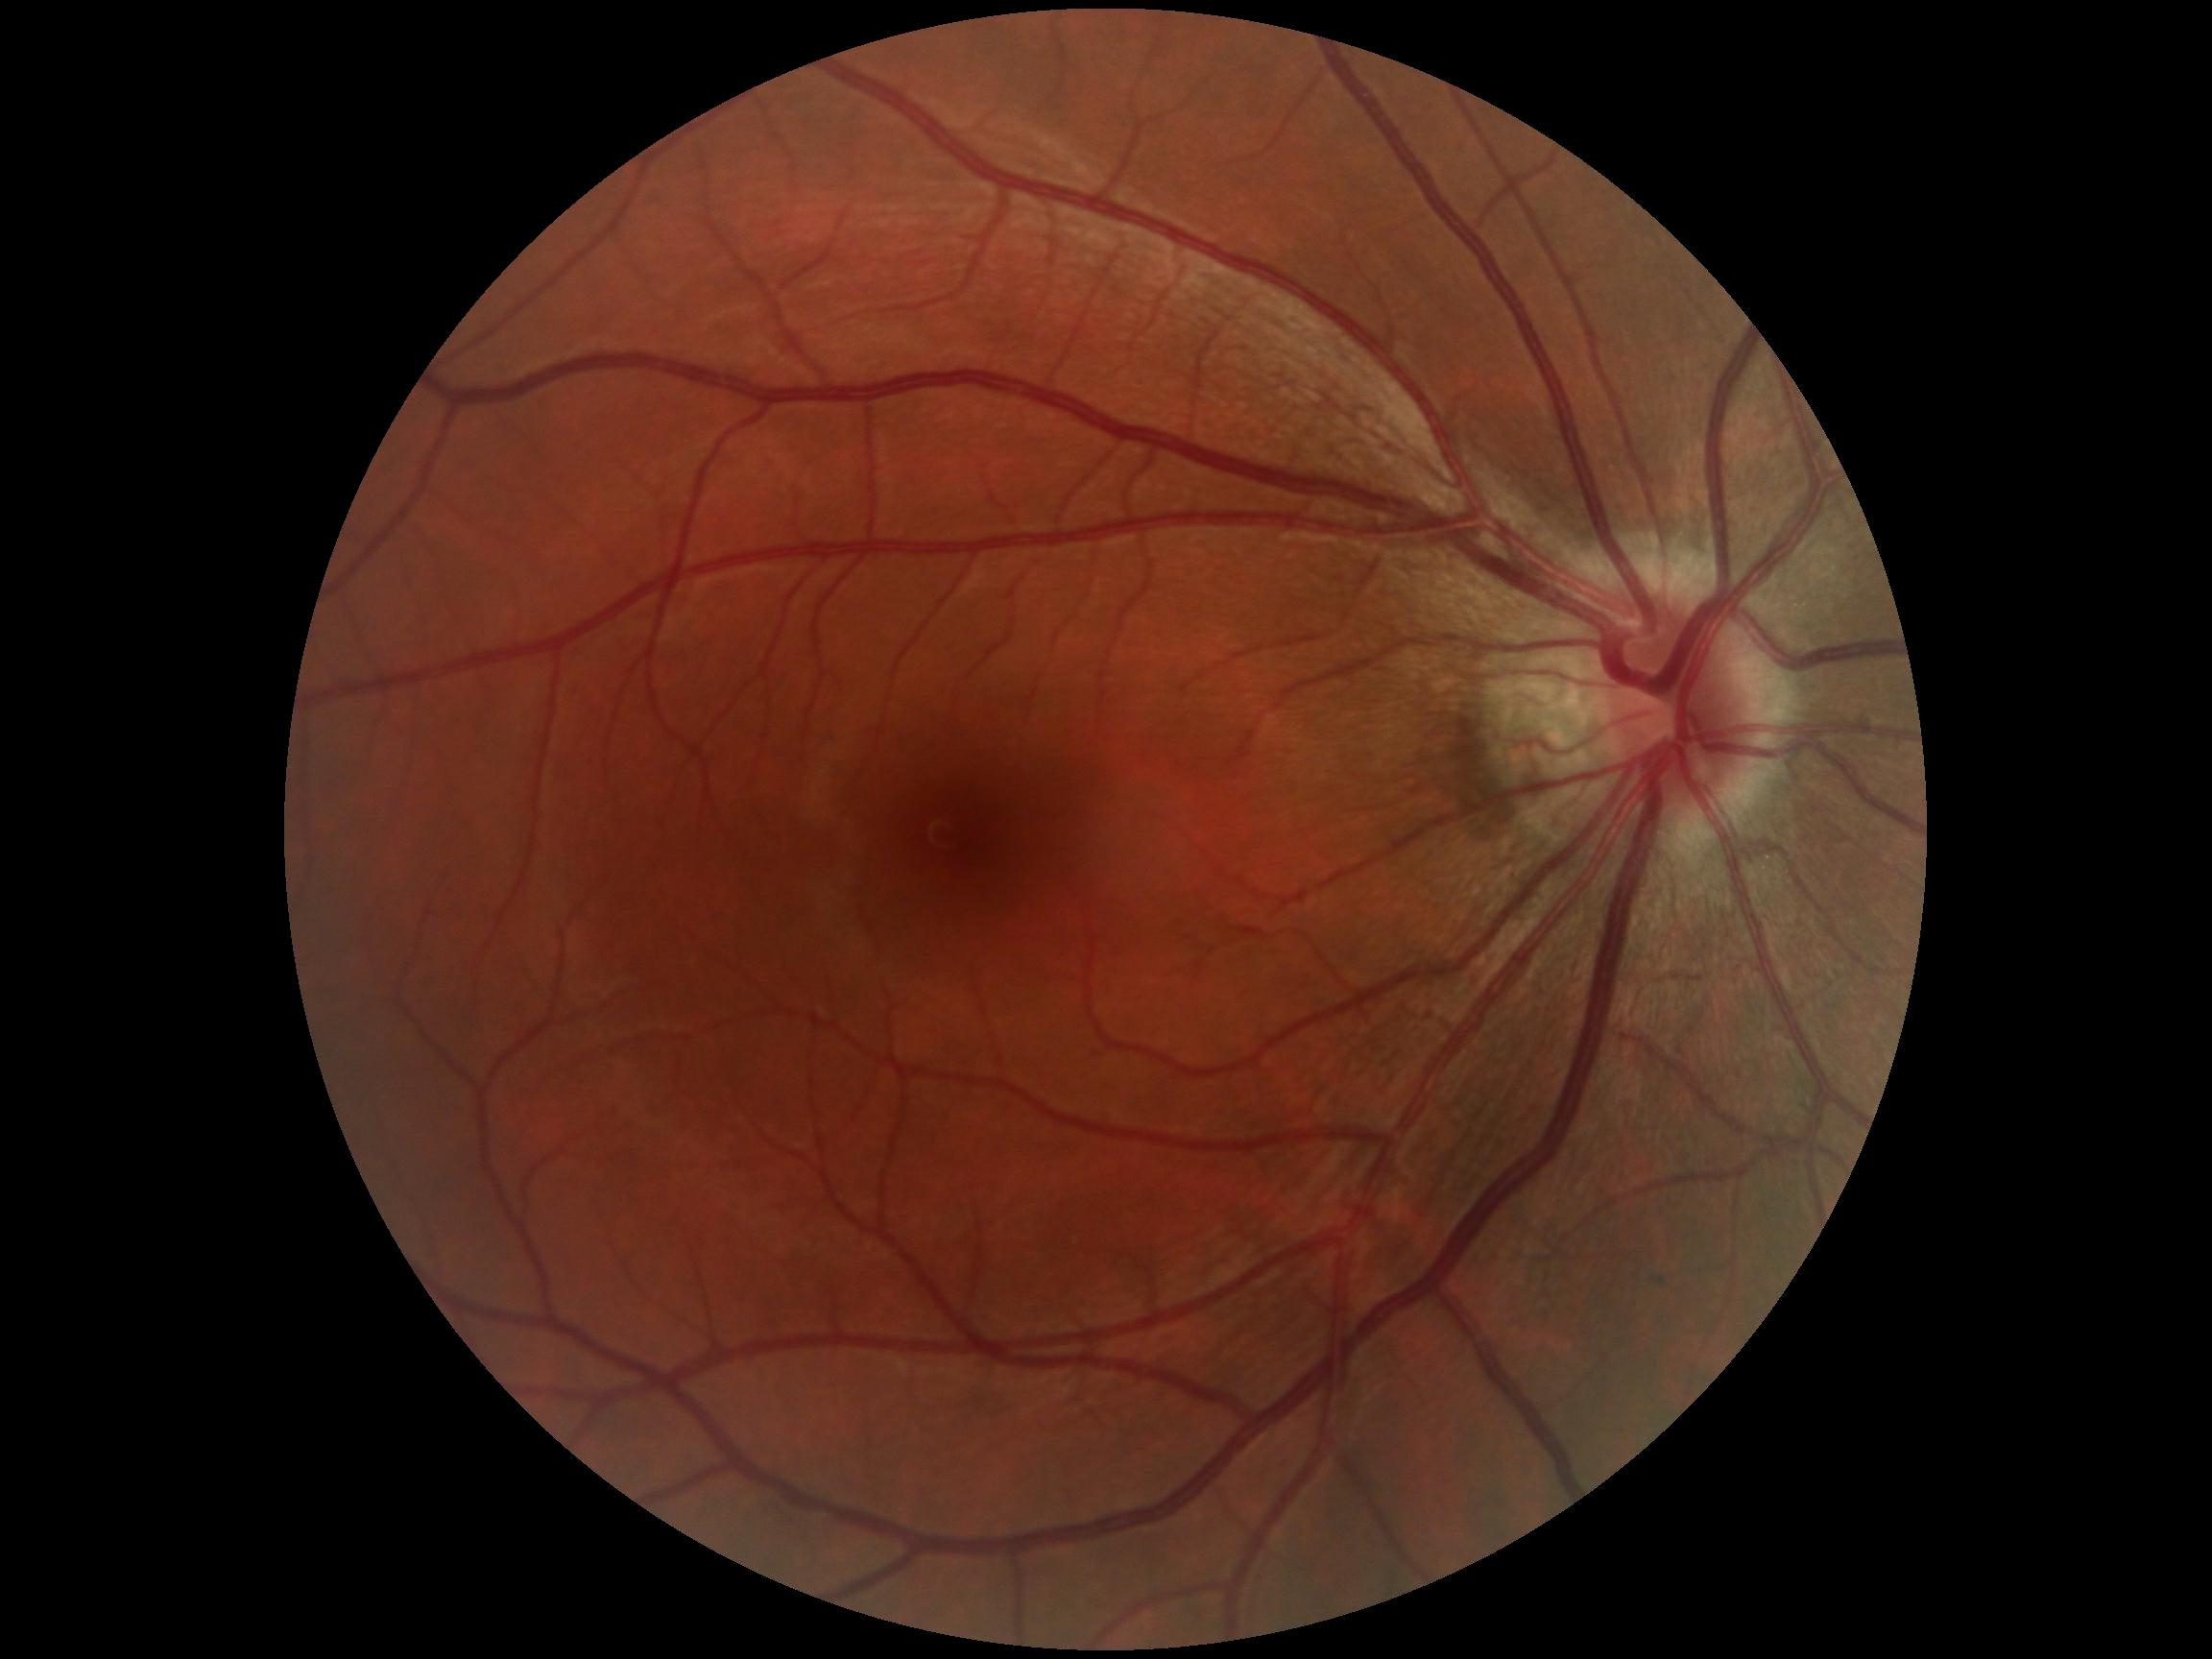
DR is 0.